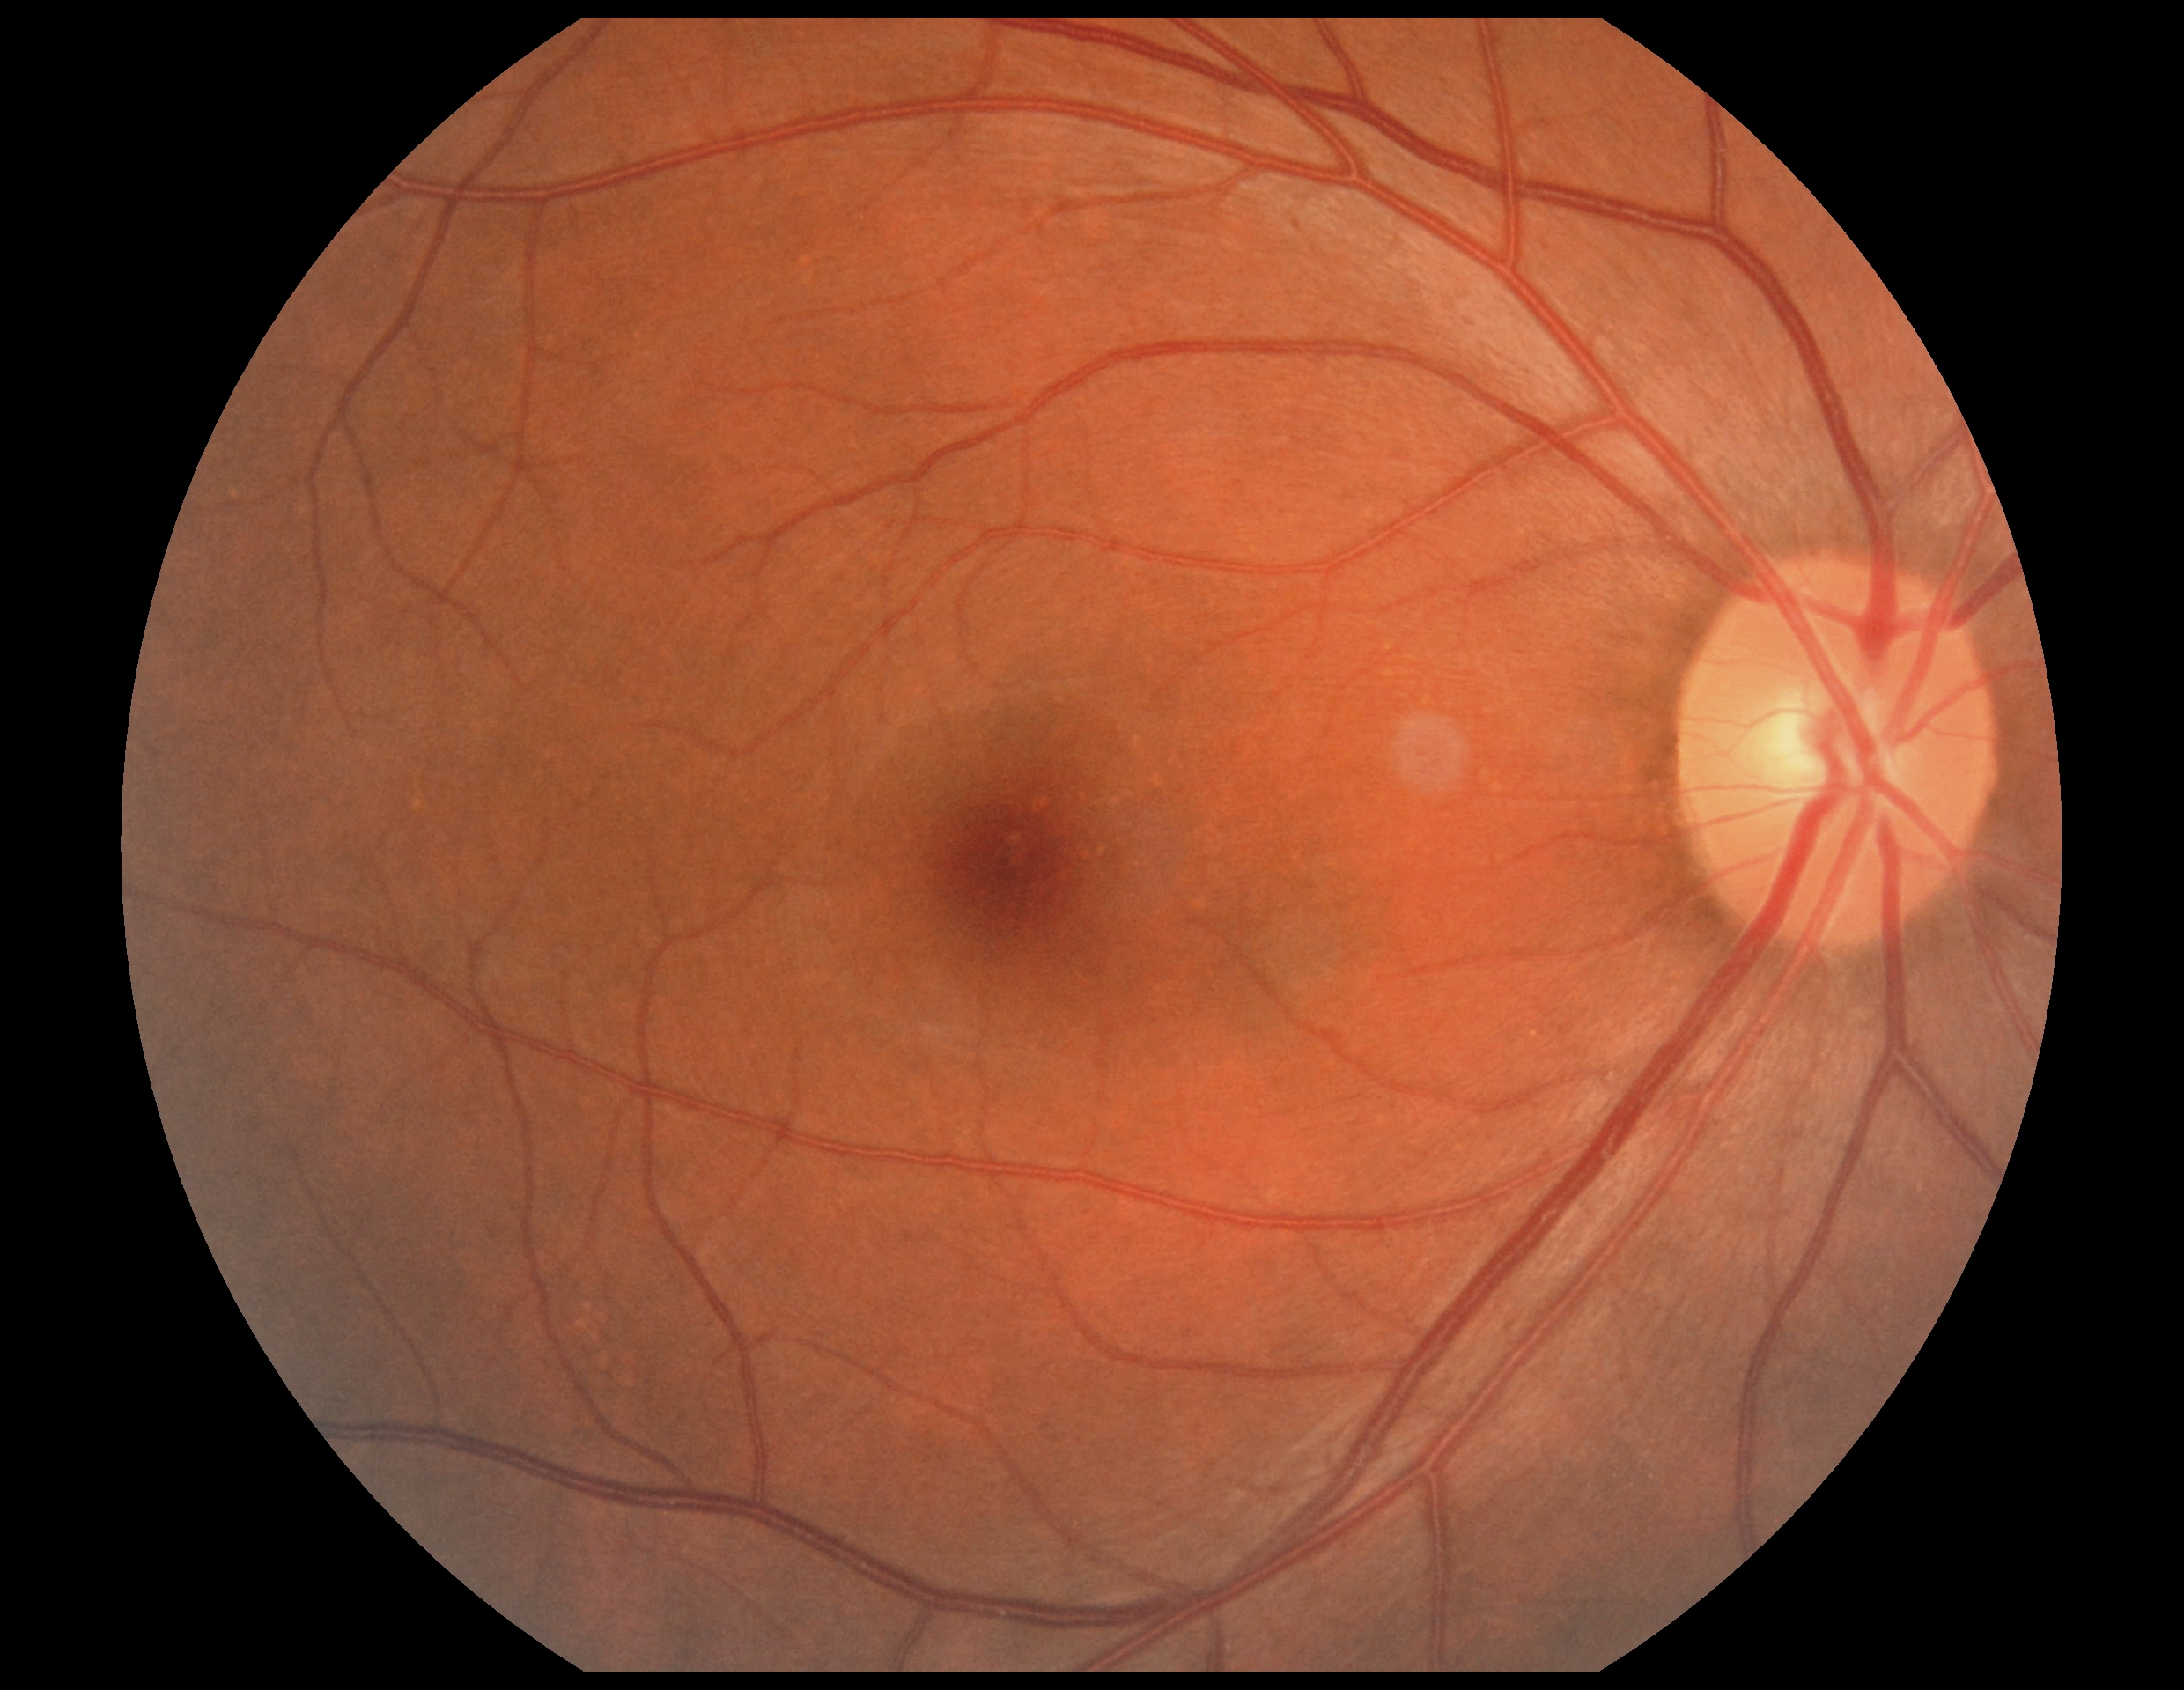
DR grade: no apparent diabetic retinopathy (0) — no visible signs of diabetic retinopathy.